512 by 512 pixels — 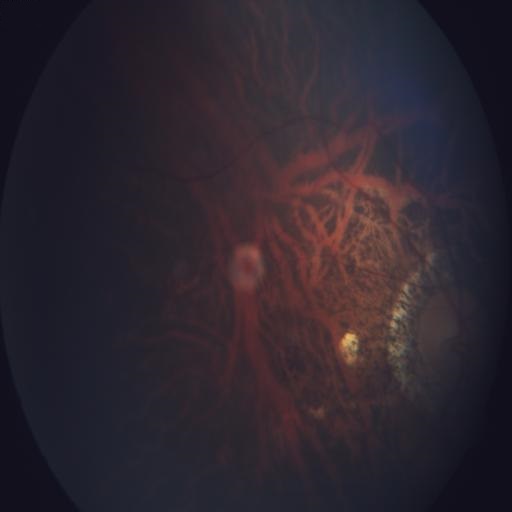
Impression:
- myopia
- optic disc cupping